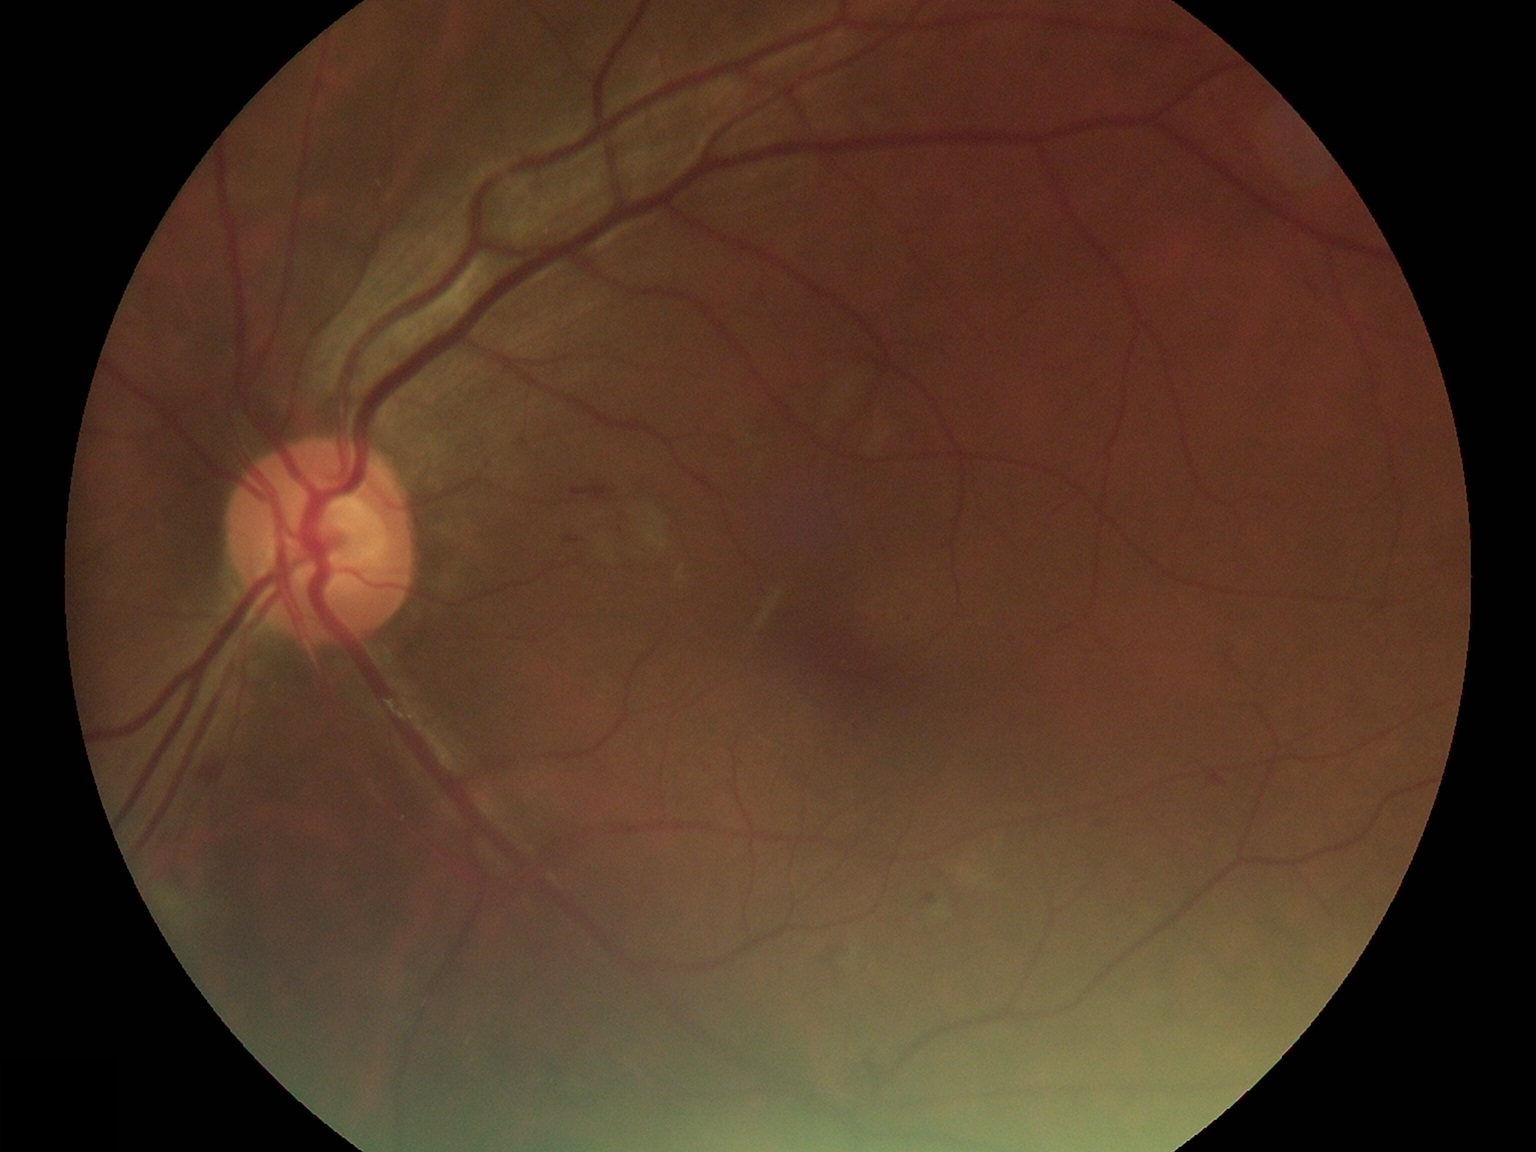 DR severity: moderate non-proliferative diabetic retinopathy (grade 2) — more than just microaneurysms but less than severe NPDR.